130° field of view (Natus RetCam Envision). Wide-field contact fundus photograph of an infant. 1440 x 1080 pixels — 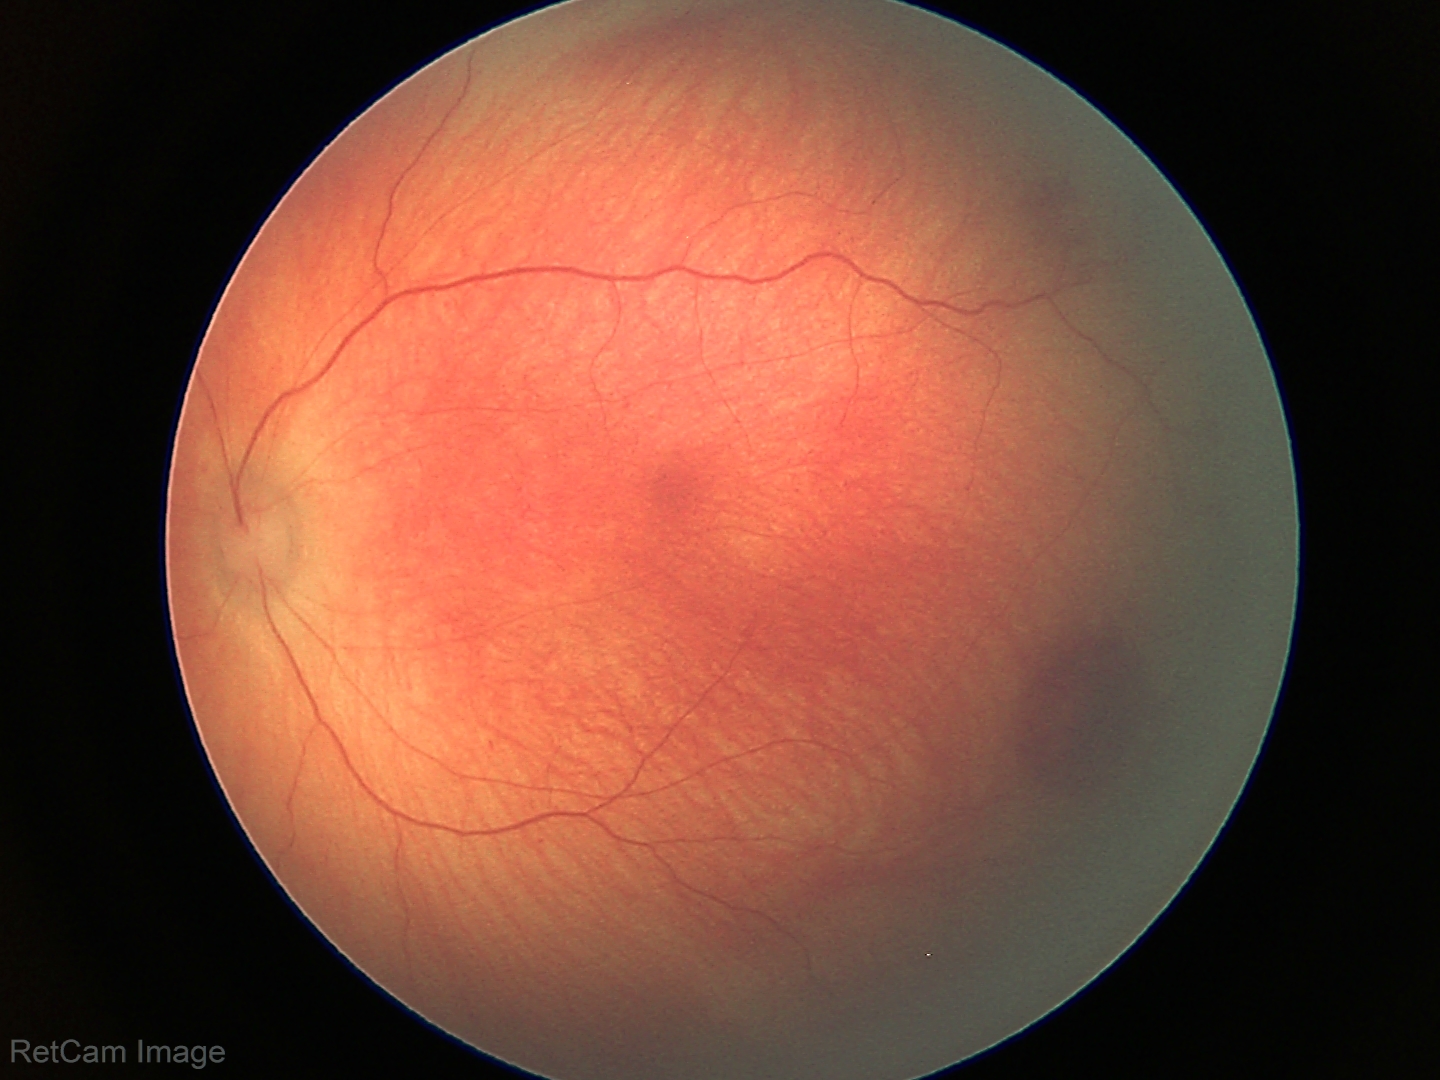

Screening diagnosis: retinal hemorrhages.